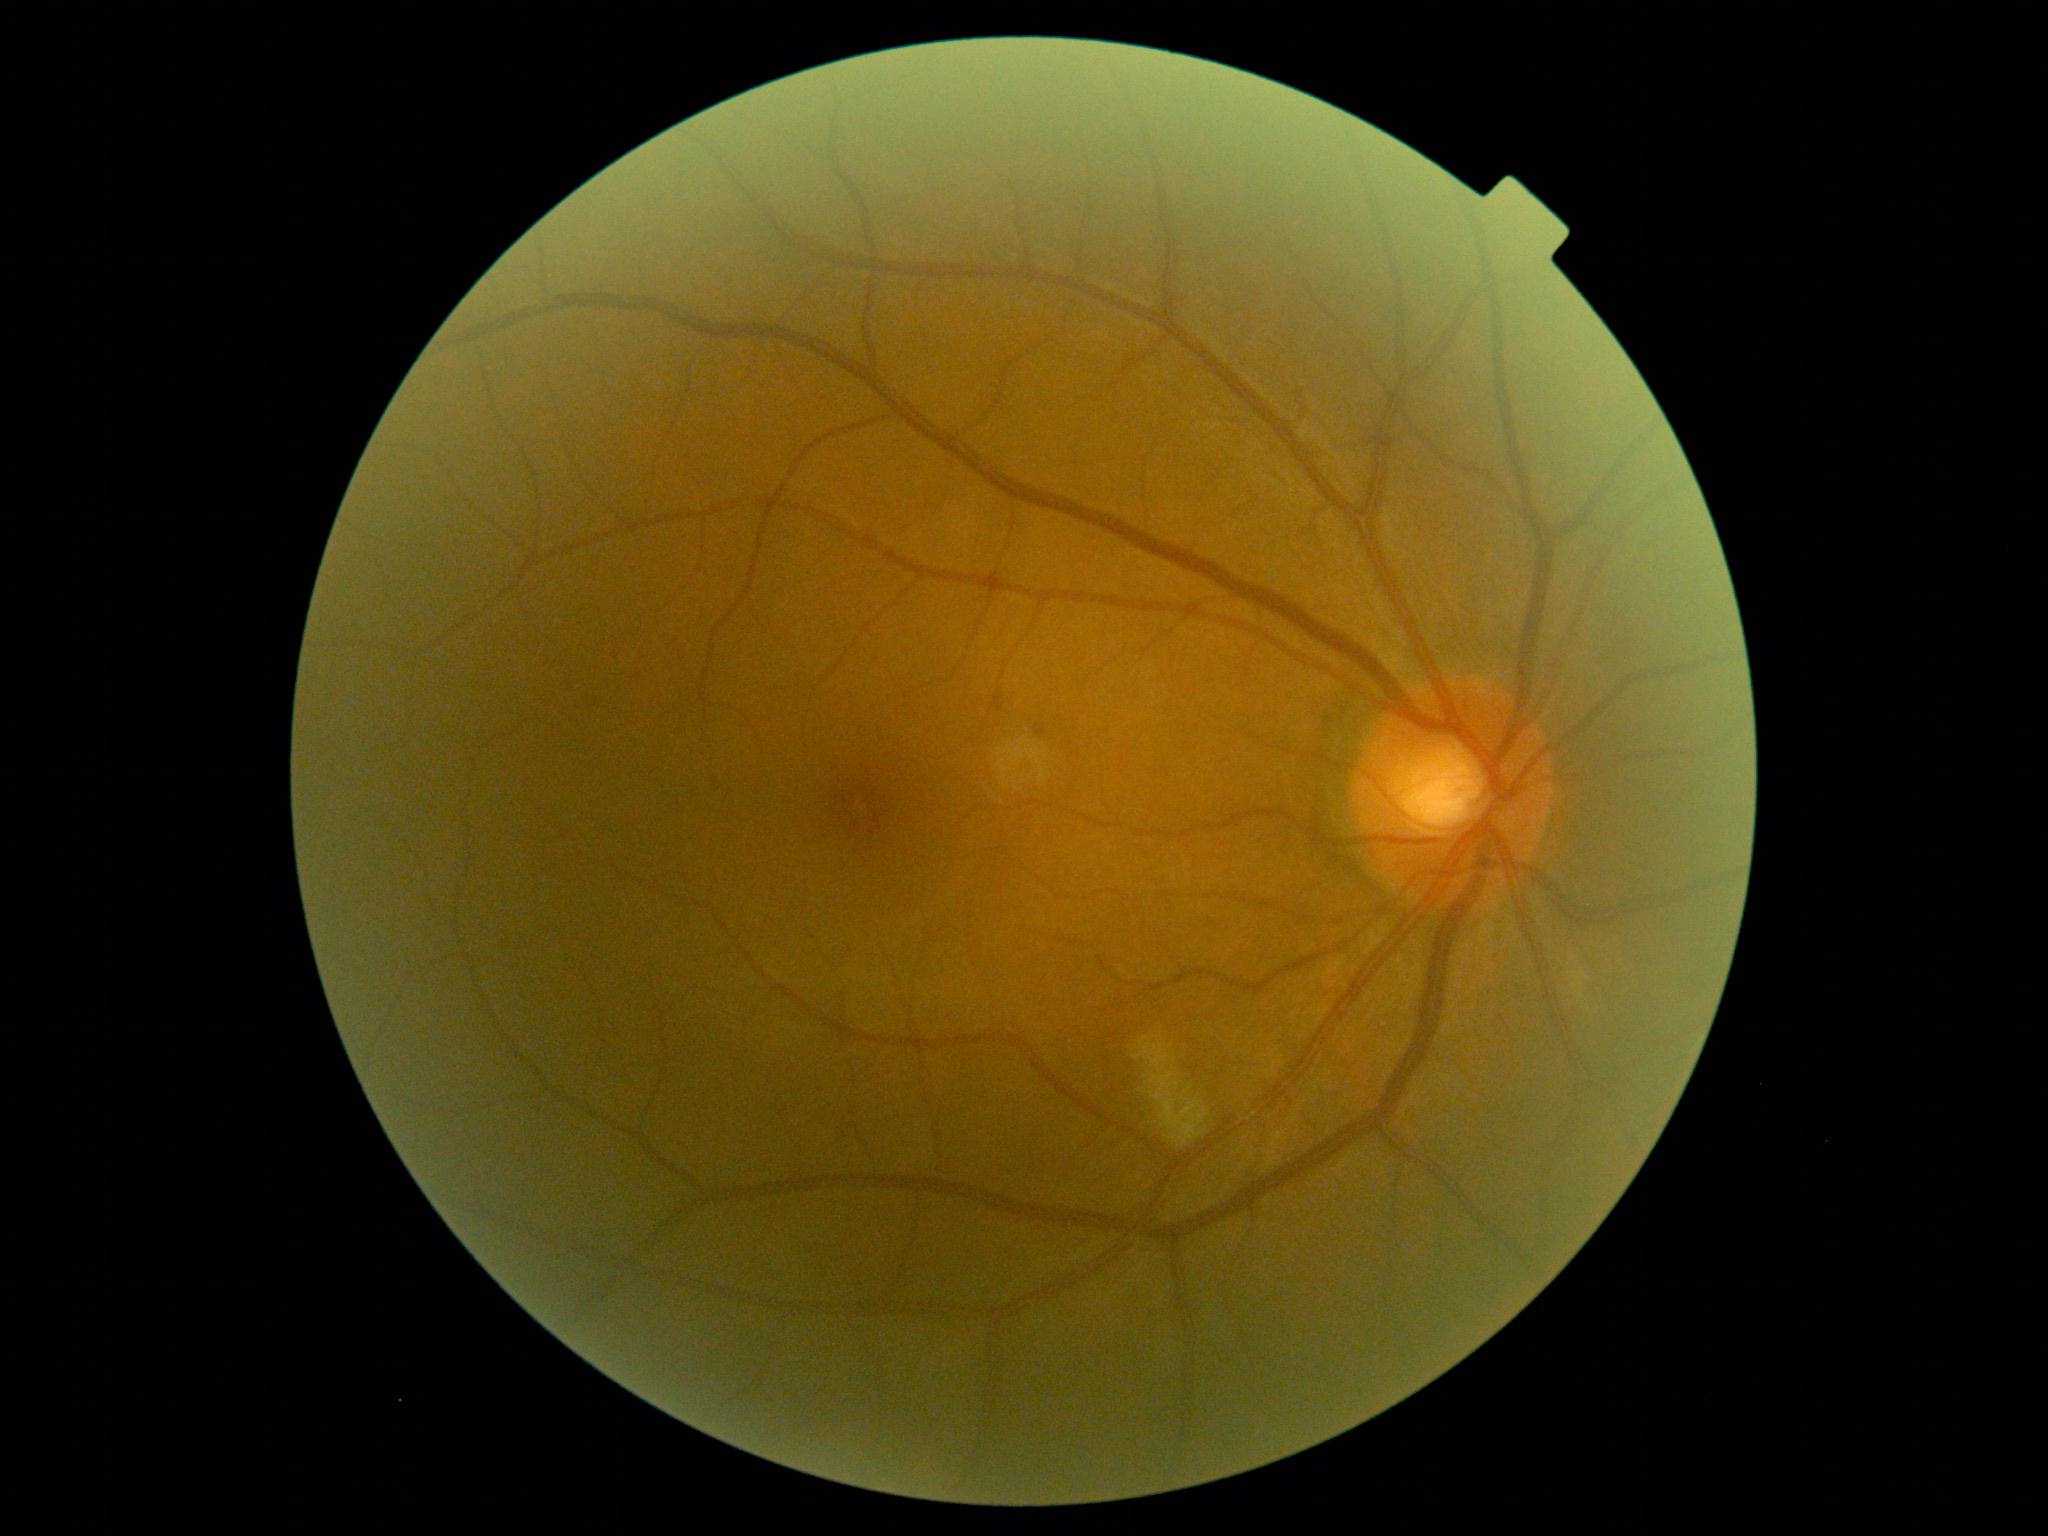

diabetic retinopathy grade: 2 — more than just microaneurysms but less than severe NPDR.